Image size 2212x1659. Color fundus photograph
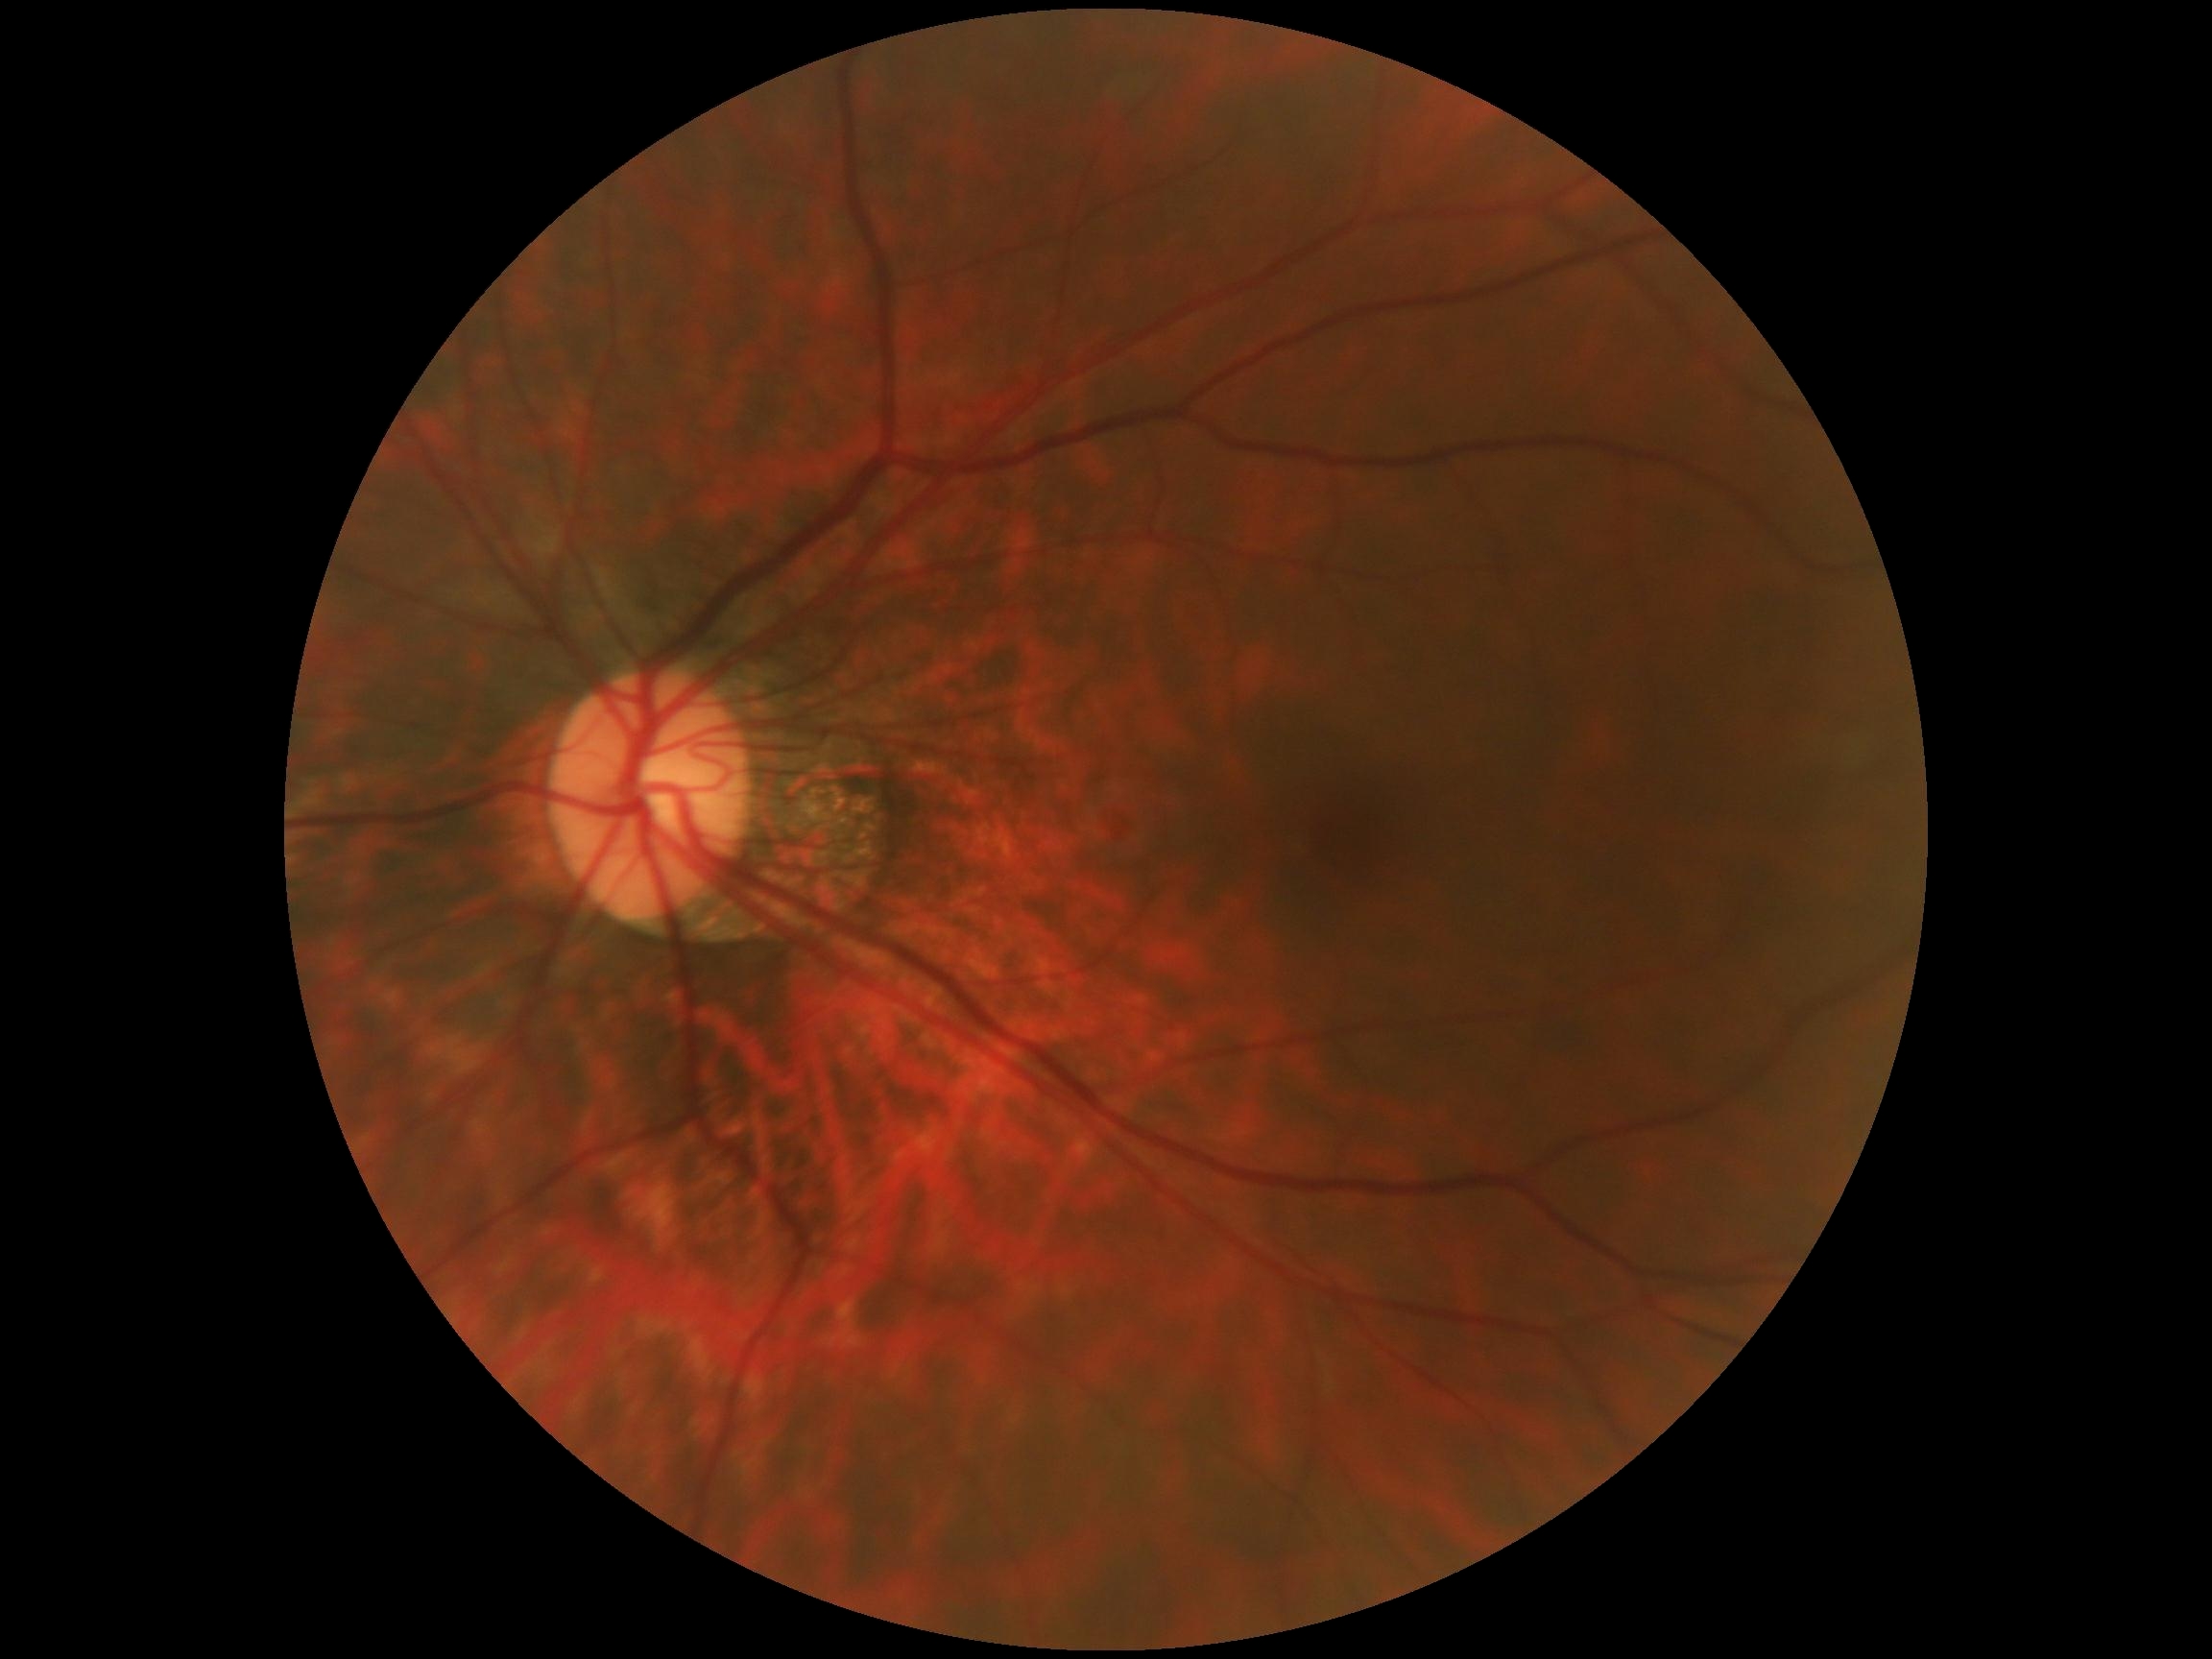
No diabetic retinal disease findings.
DR is 0/4.